Captured on a Topcon TRC retinal camera · color fundus photograph centered on the optic disc · 364x364: 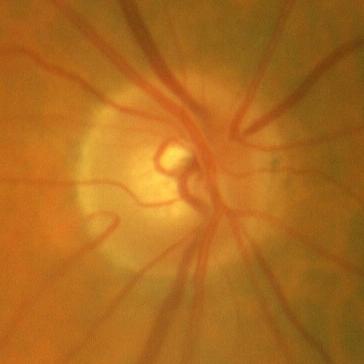

Q: Does this eye have glaucoma?
A: No — no glaucomatous damage.